2228x1652 · 50° field of view · posterior pole view
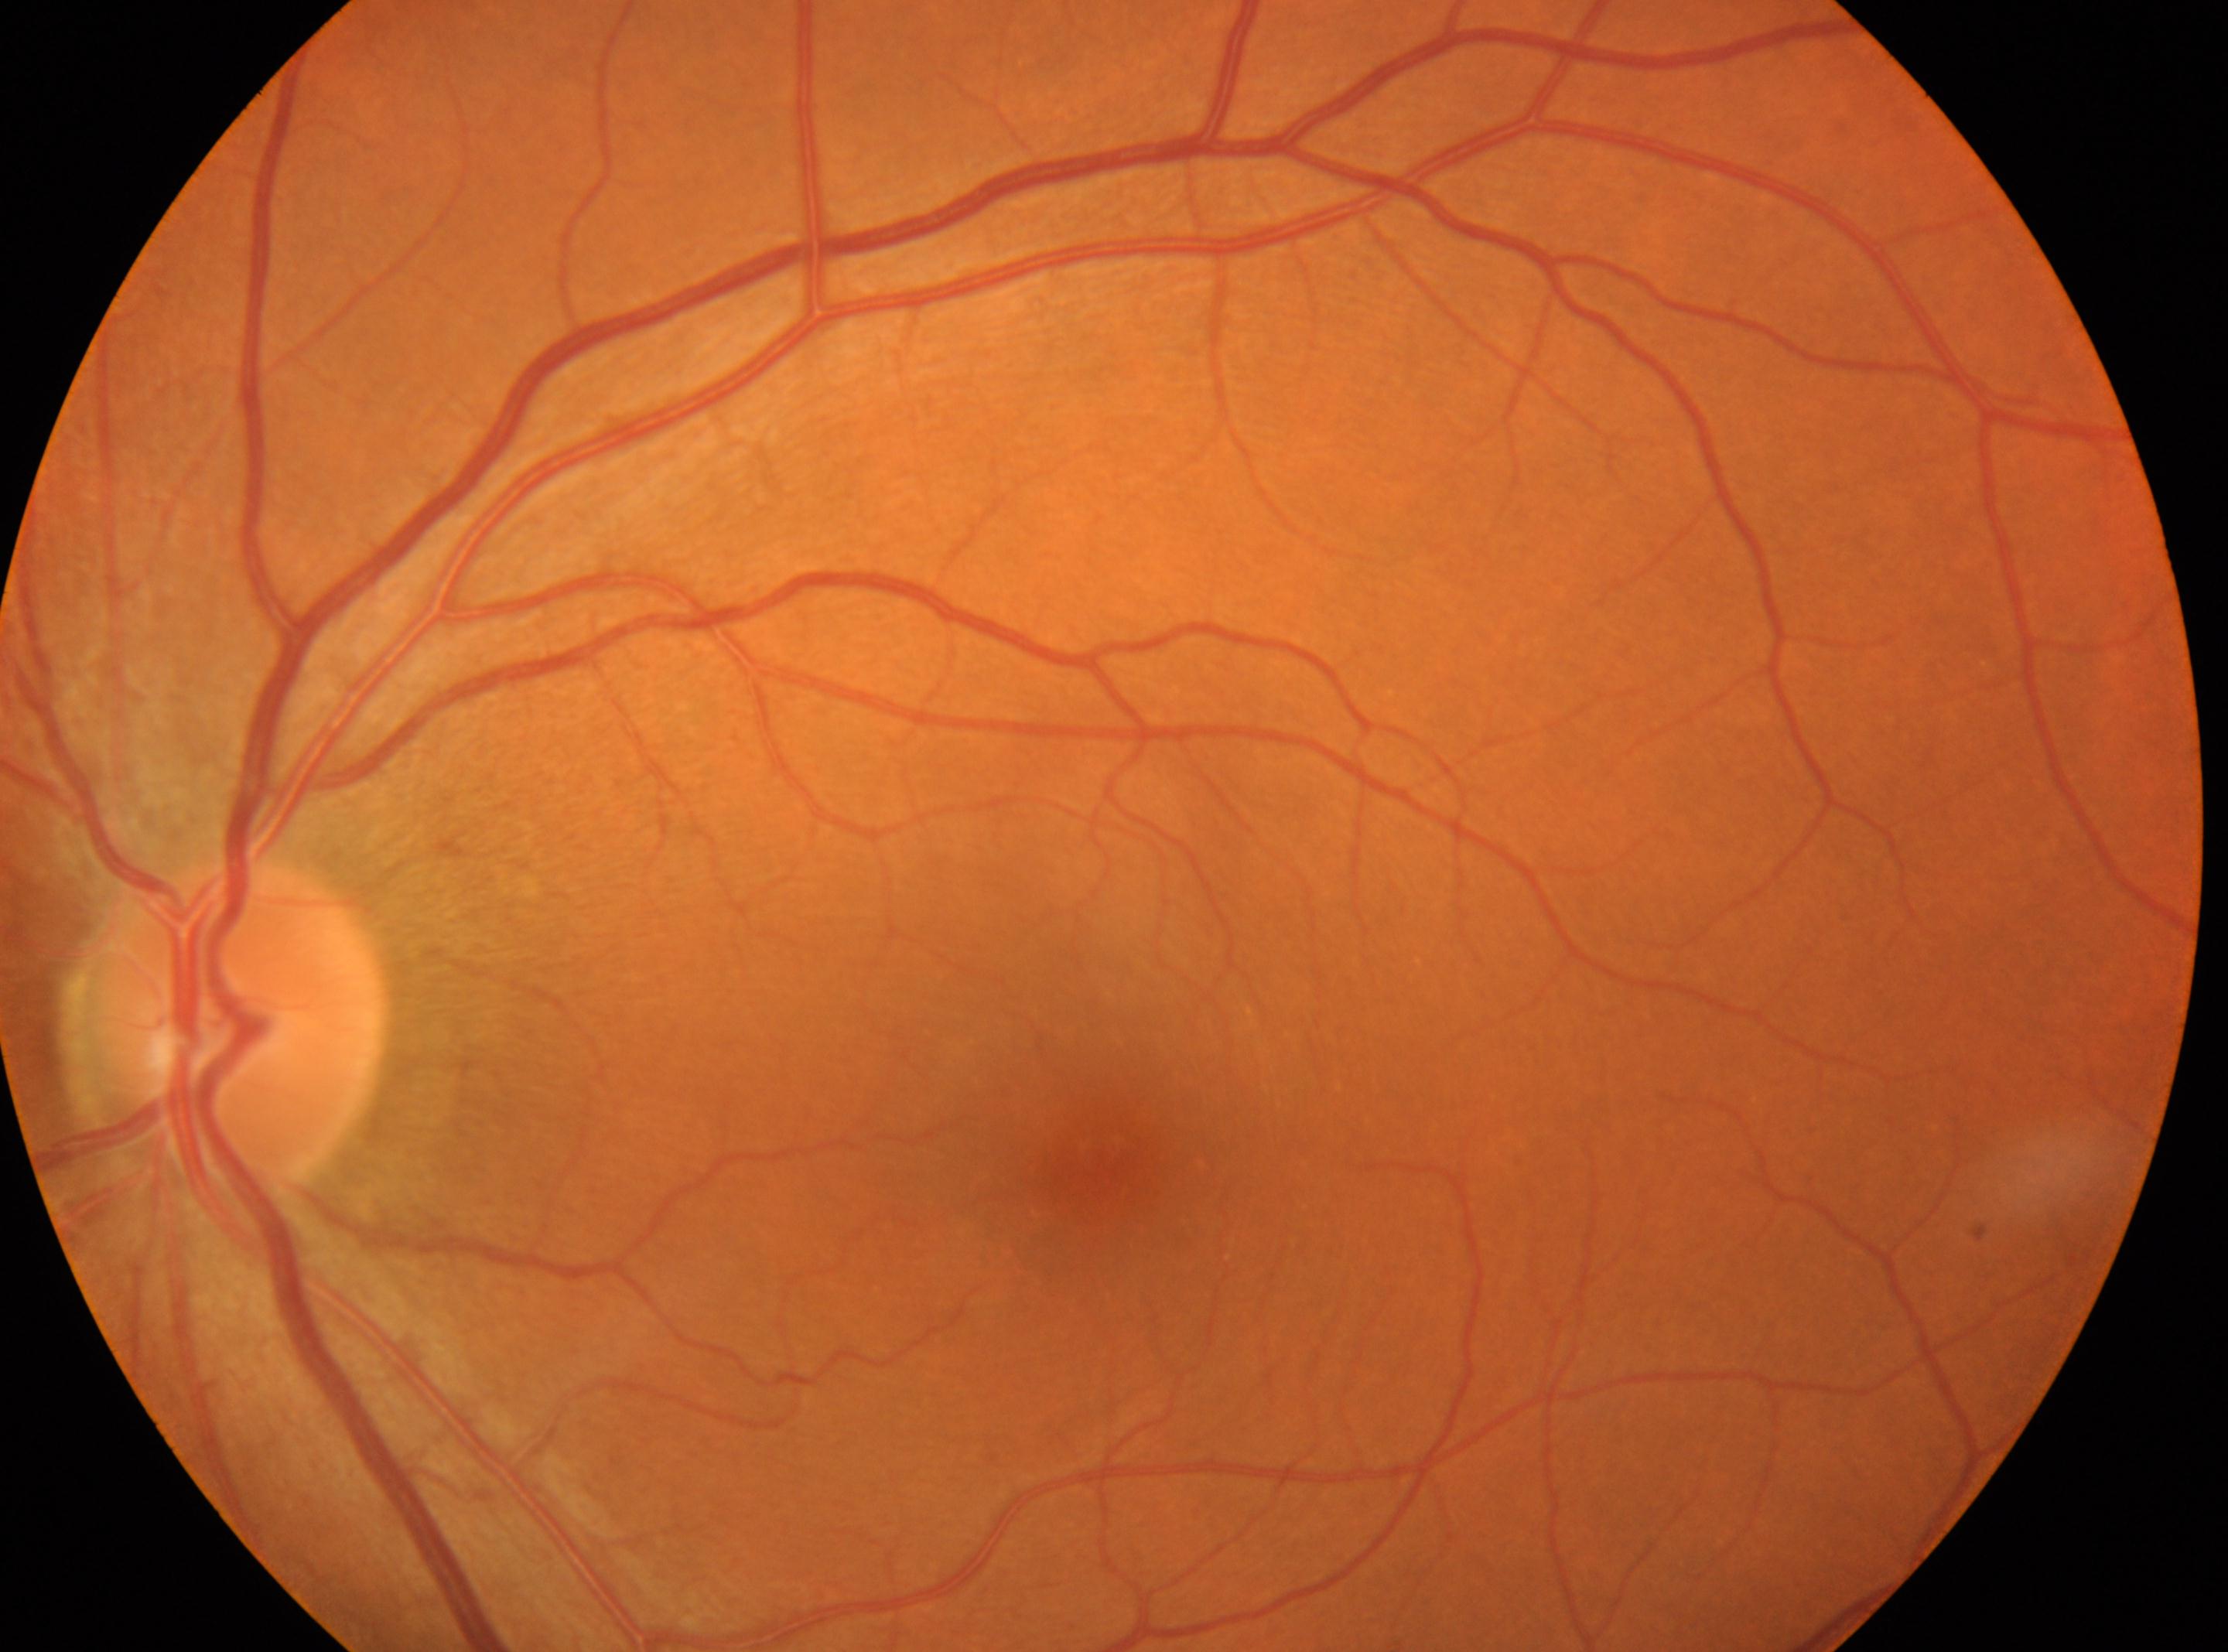
The macular center is at (1083, 1190). Optic disc center located at (238, 1026). Retinopathy grade is 0/4. The image shows the OS.